Pediatric wide-field fundus photograph. 1240 by 1240 pixels. Captured with the Phoenix ICON (100° field of view):
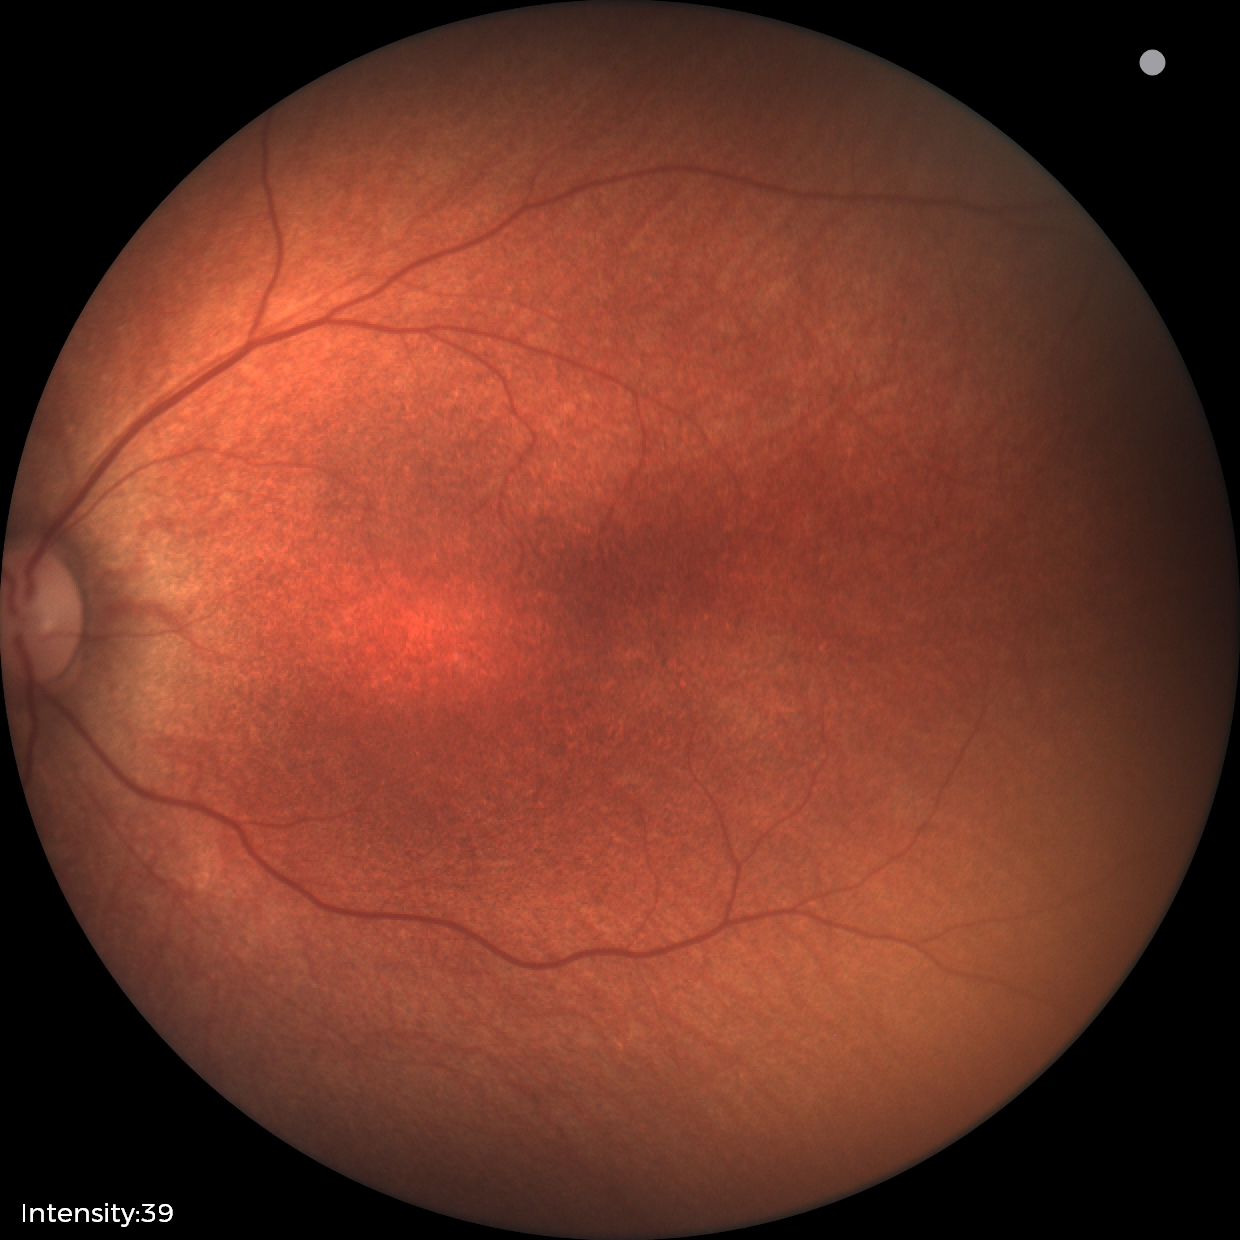 Screening examination diagnosed as physiological.